848x848px; color fundus photograph.
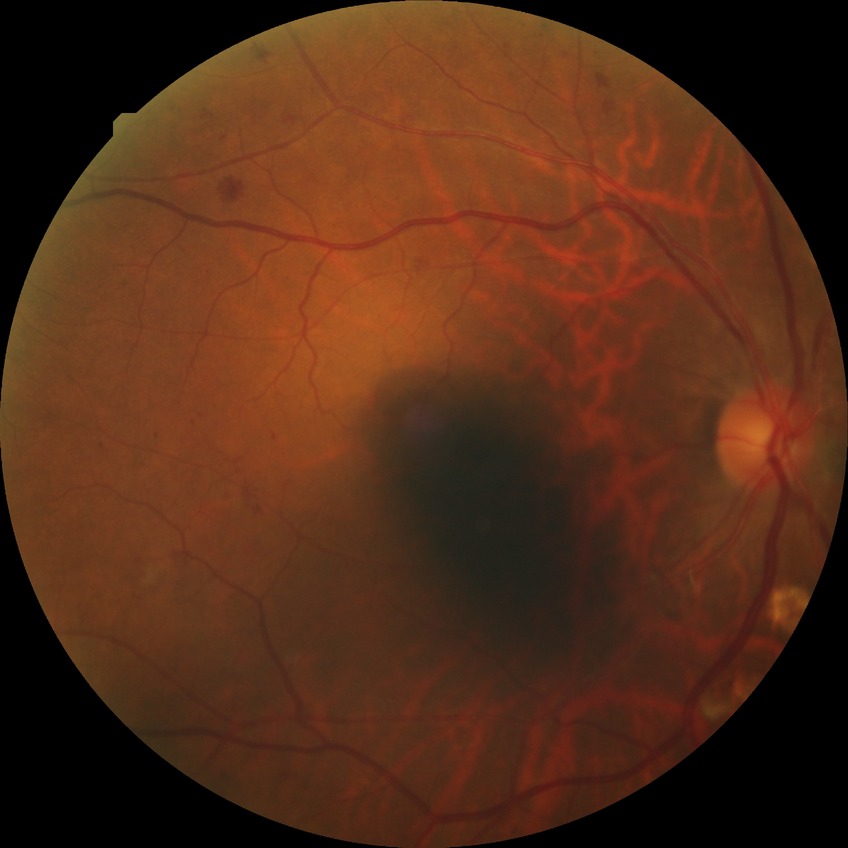

  proliferative_class: non-proliferative diabetic retinopathy
  davis_grade: pre-proliferative diabetic retinopathy (PPDR)